Modified Davis grading; nonmydriatic; 45° field of view: 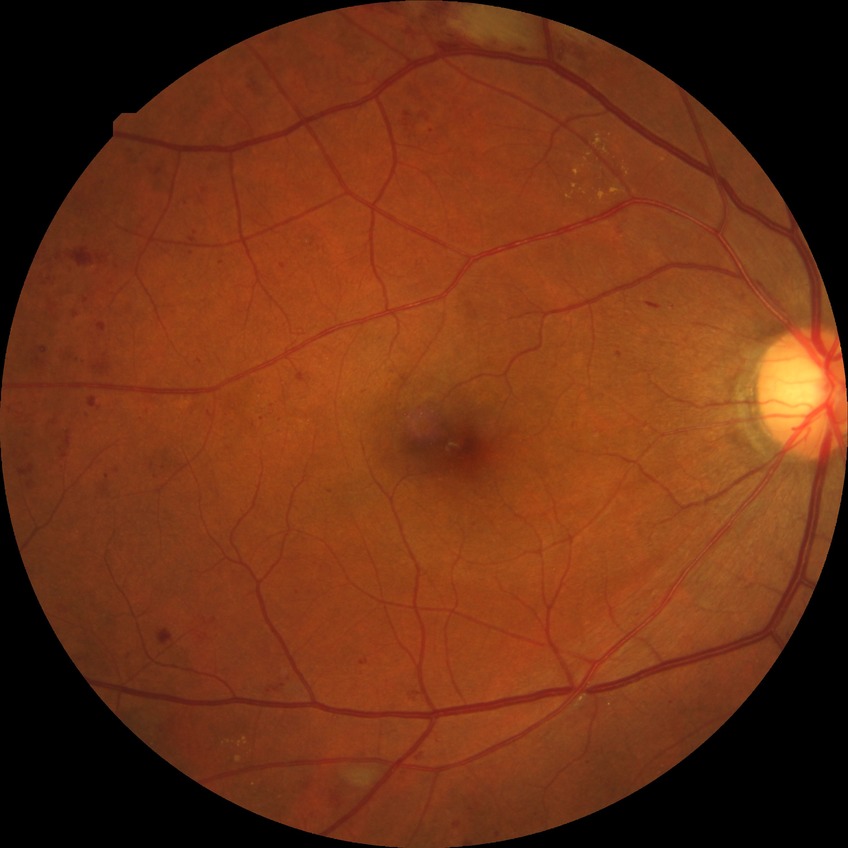 Annotations:
• diabetic retinopathy (DR) — pre-proliferative diabetic retinopathy (PPDR)